Color fundus image · 848 x 848 pixels · nonmydriatic · NIDEK AFC-230 fundus camera
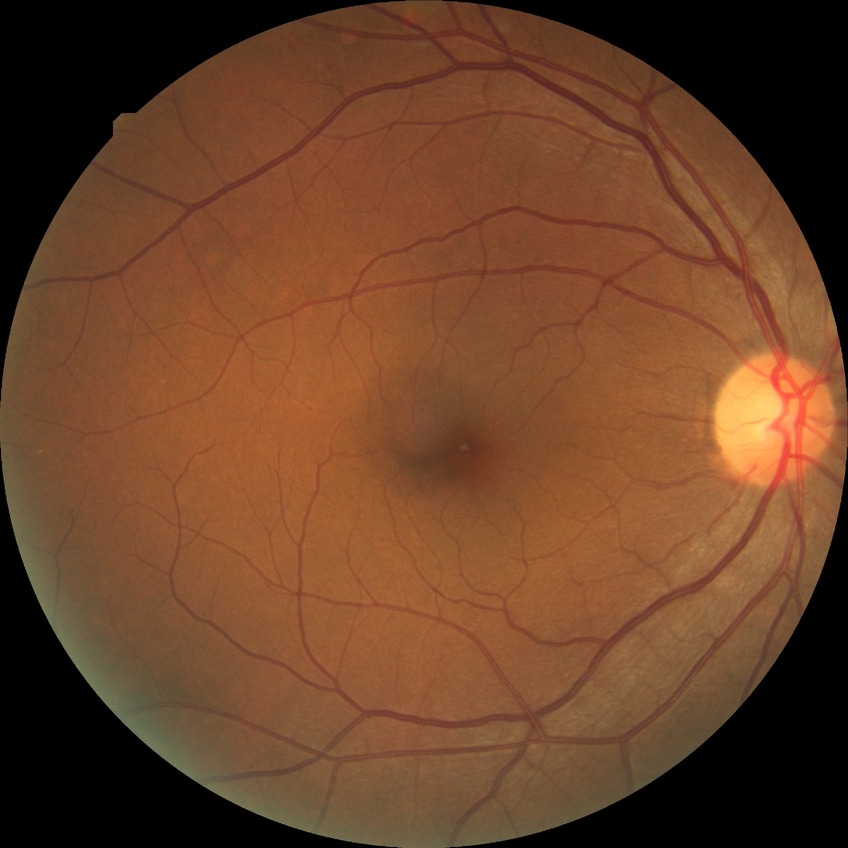

Retinopathy grade is no diabetic retinopathy.